45° field of view:
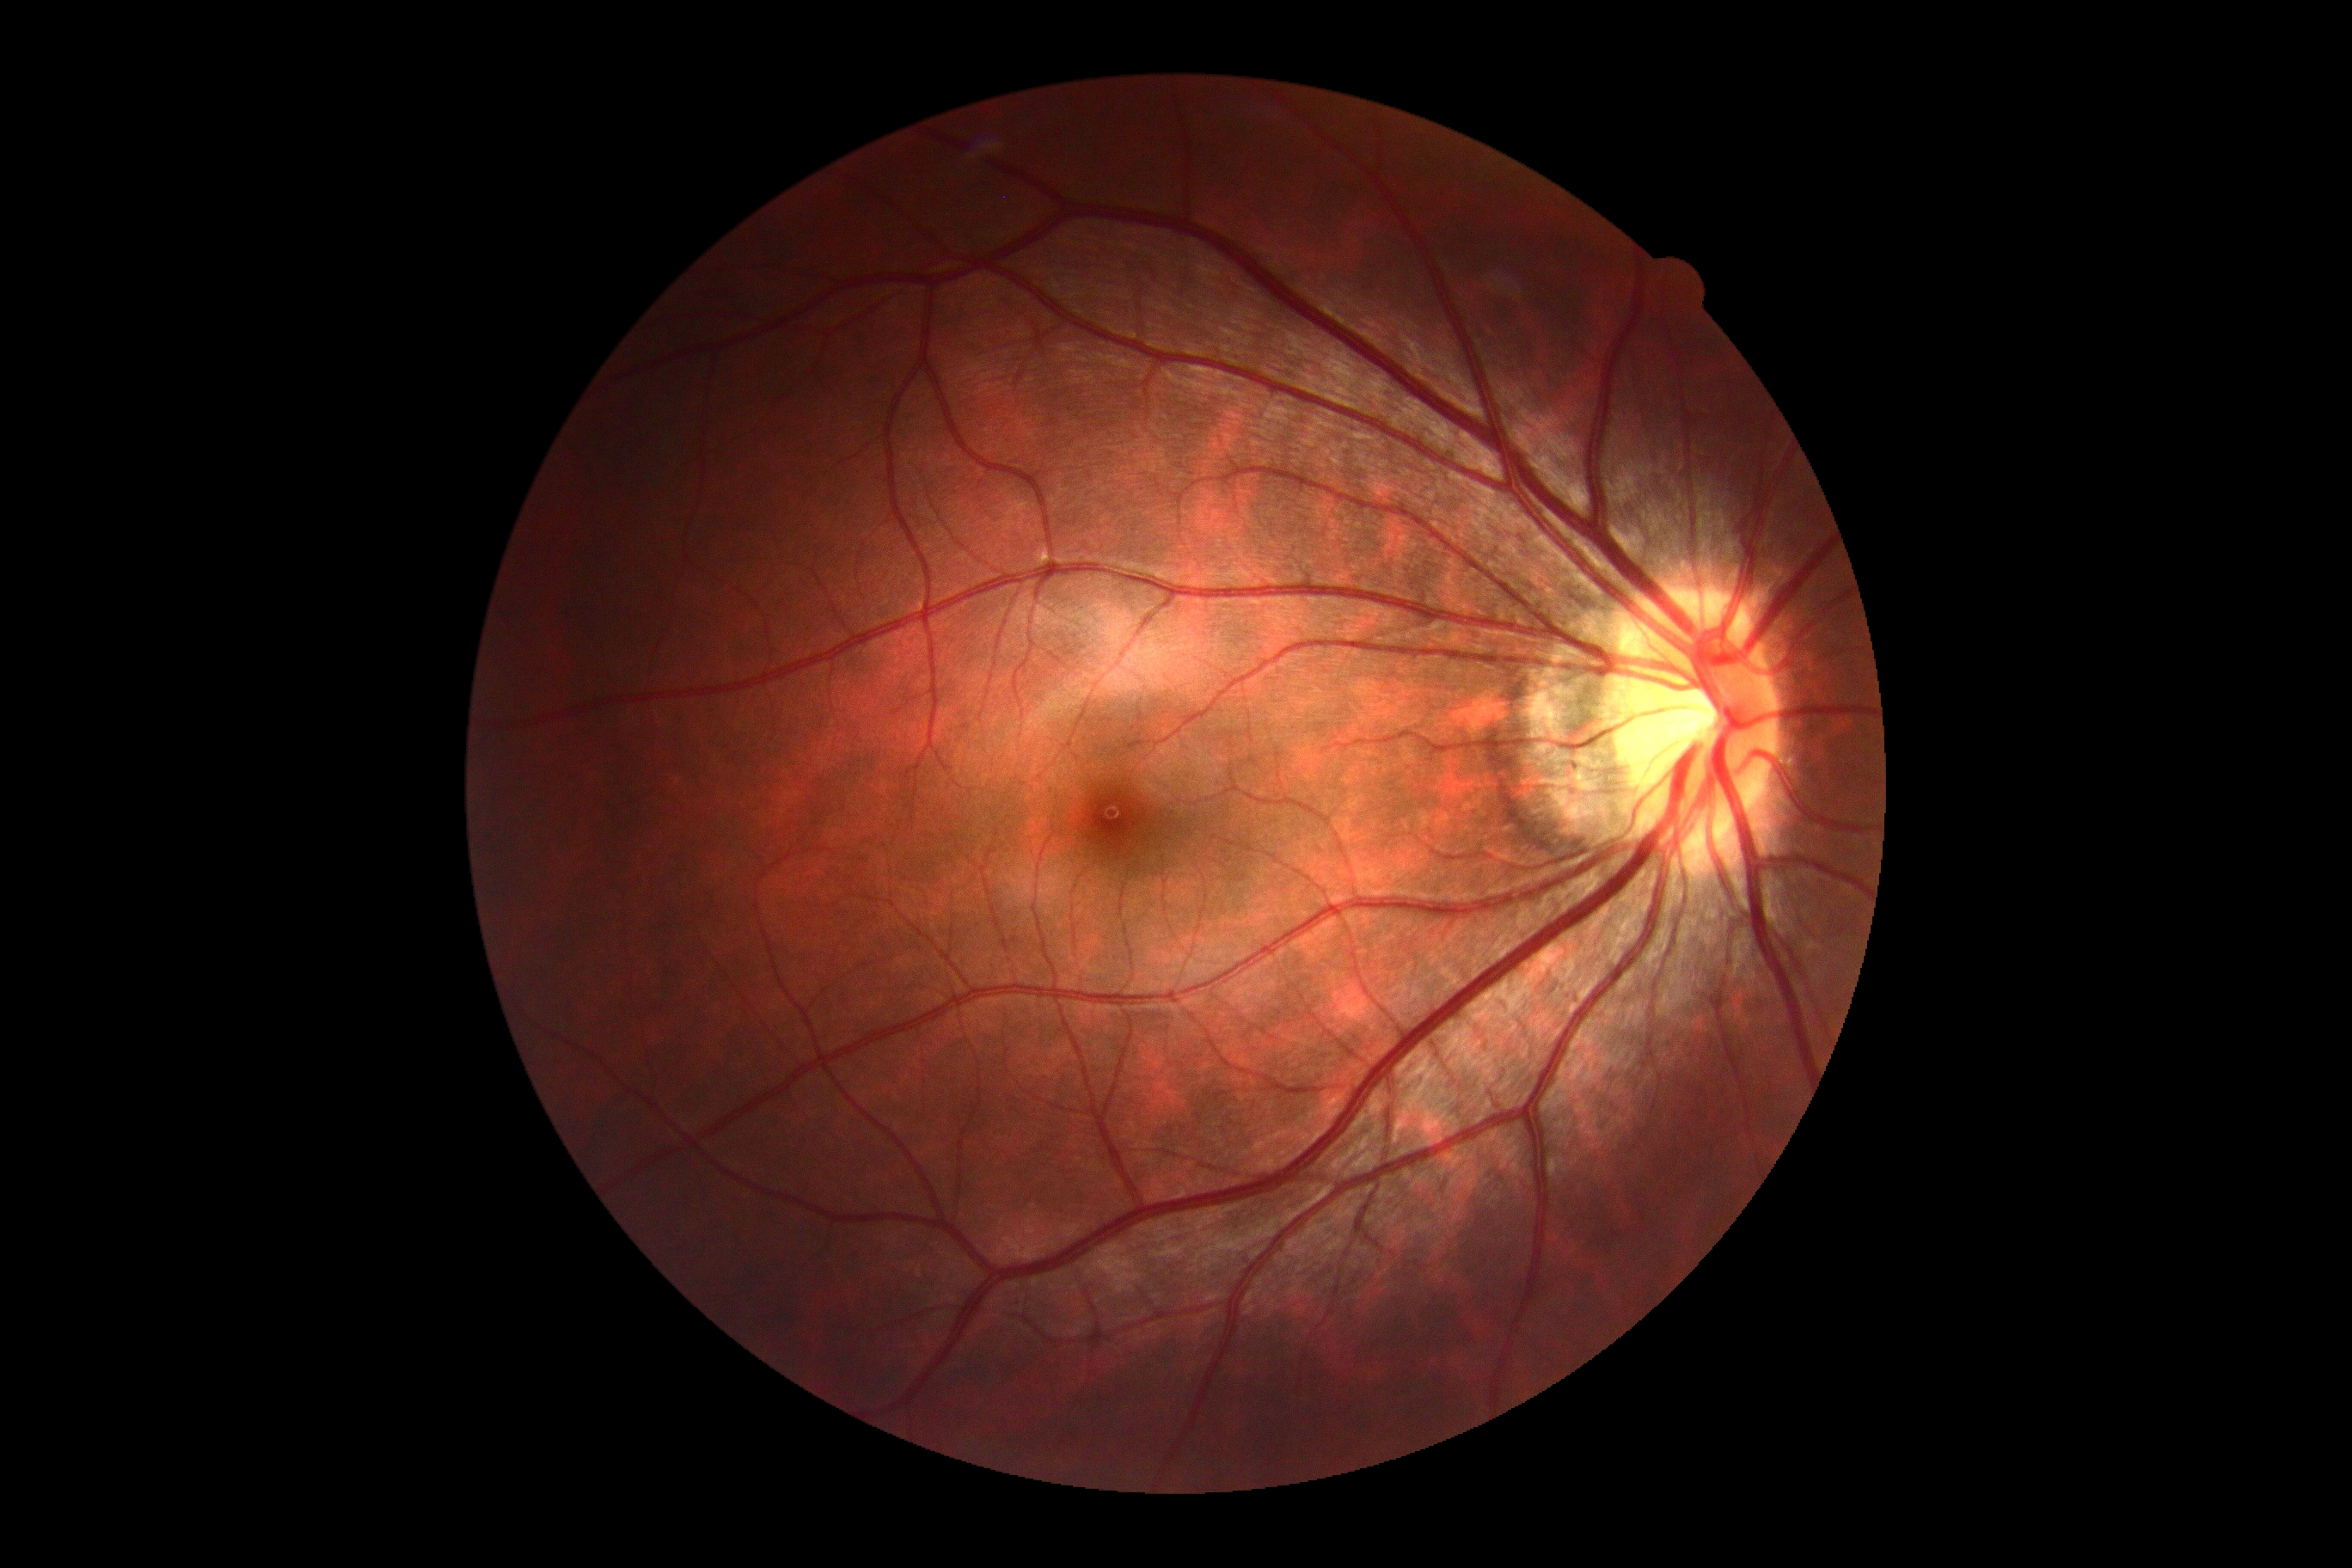
No signs of diabetic retinopathy.
Diabetic retinopathy grade is 0 (no apparent retinopathy) — no visible signs of diabetic retinopathy.